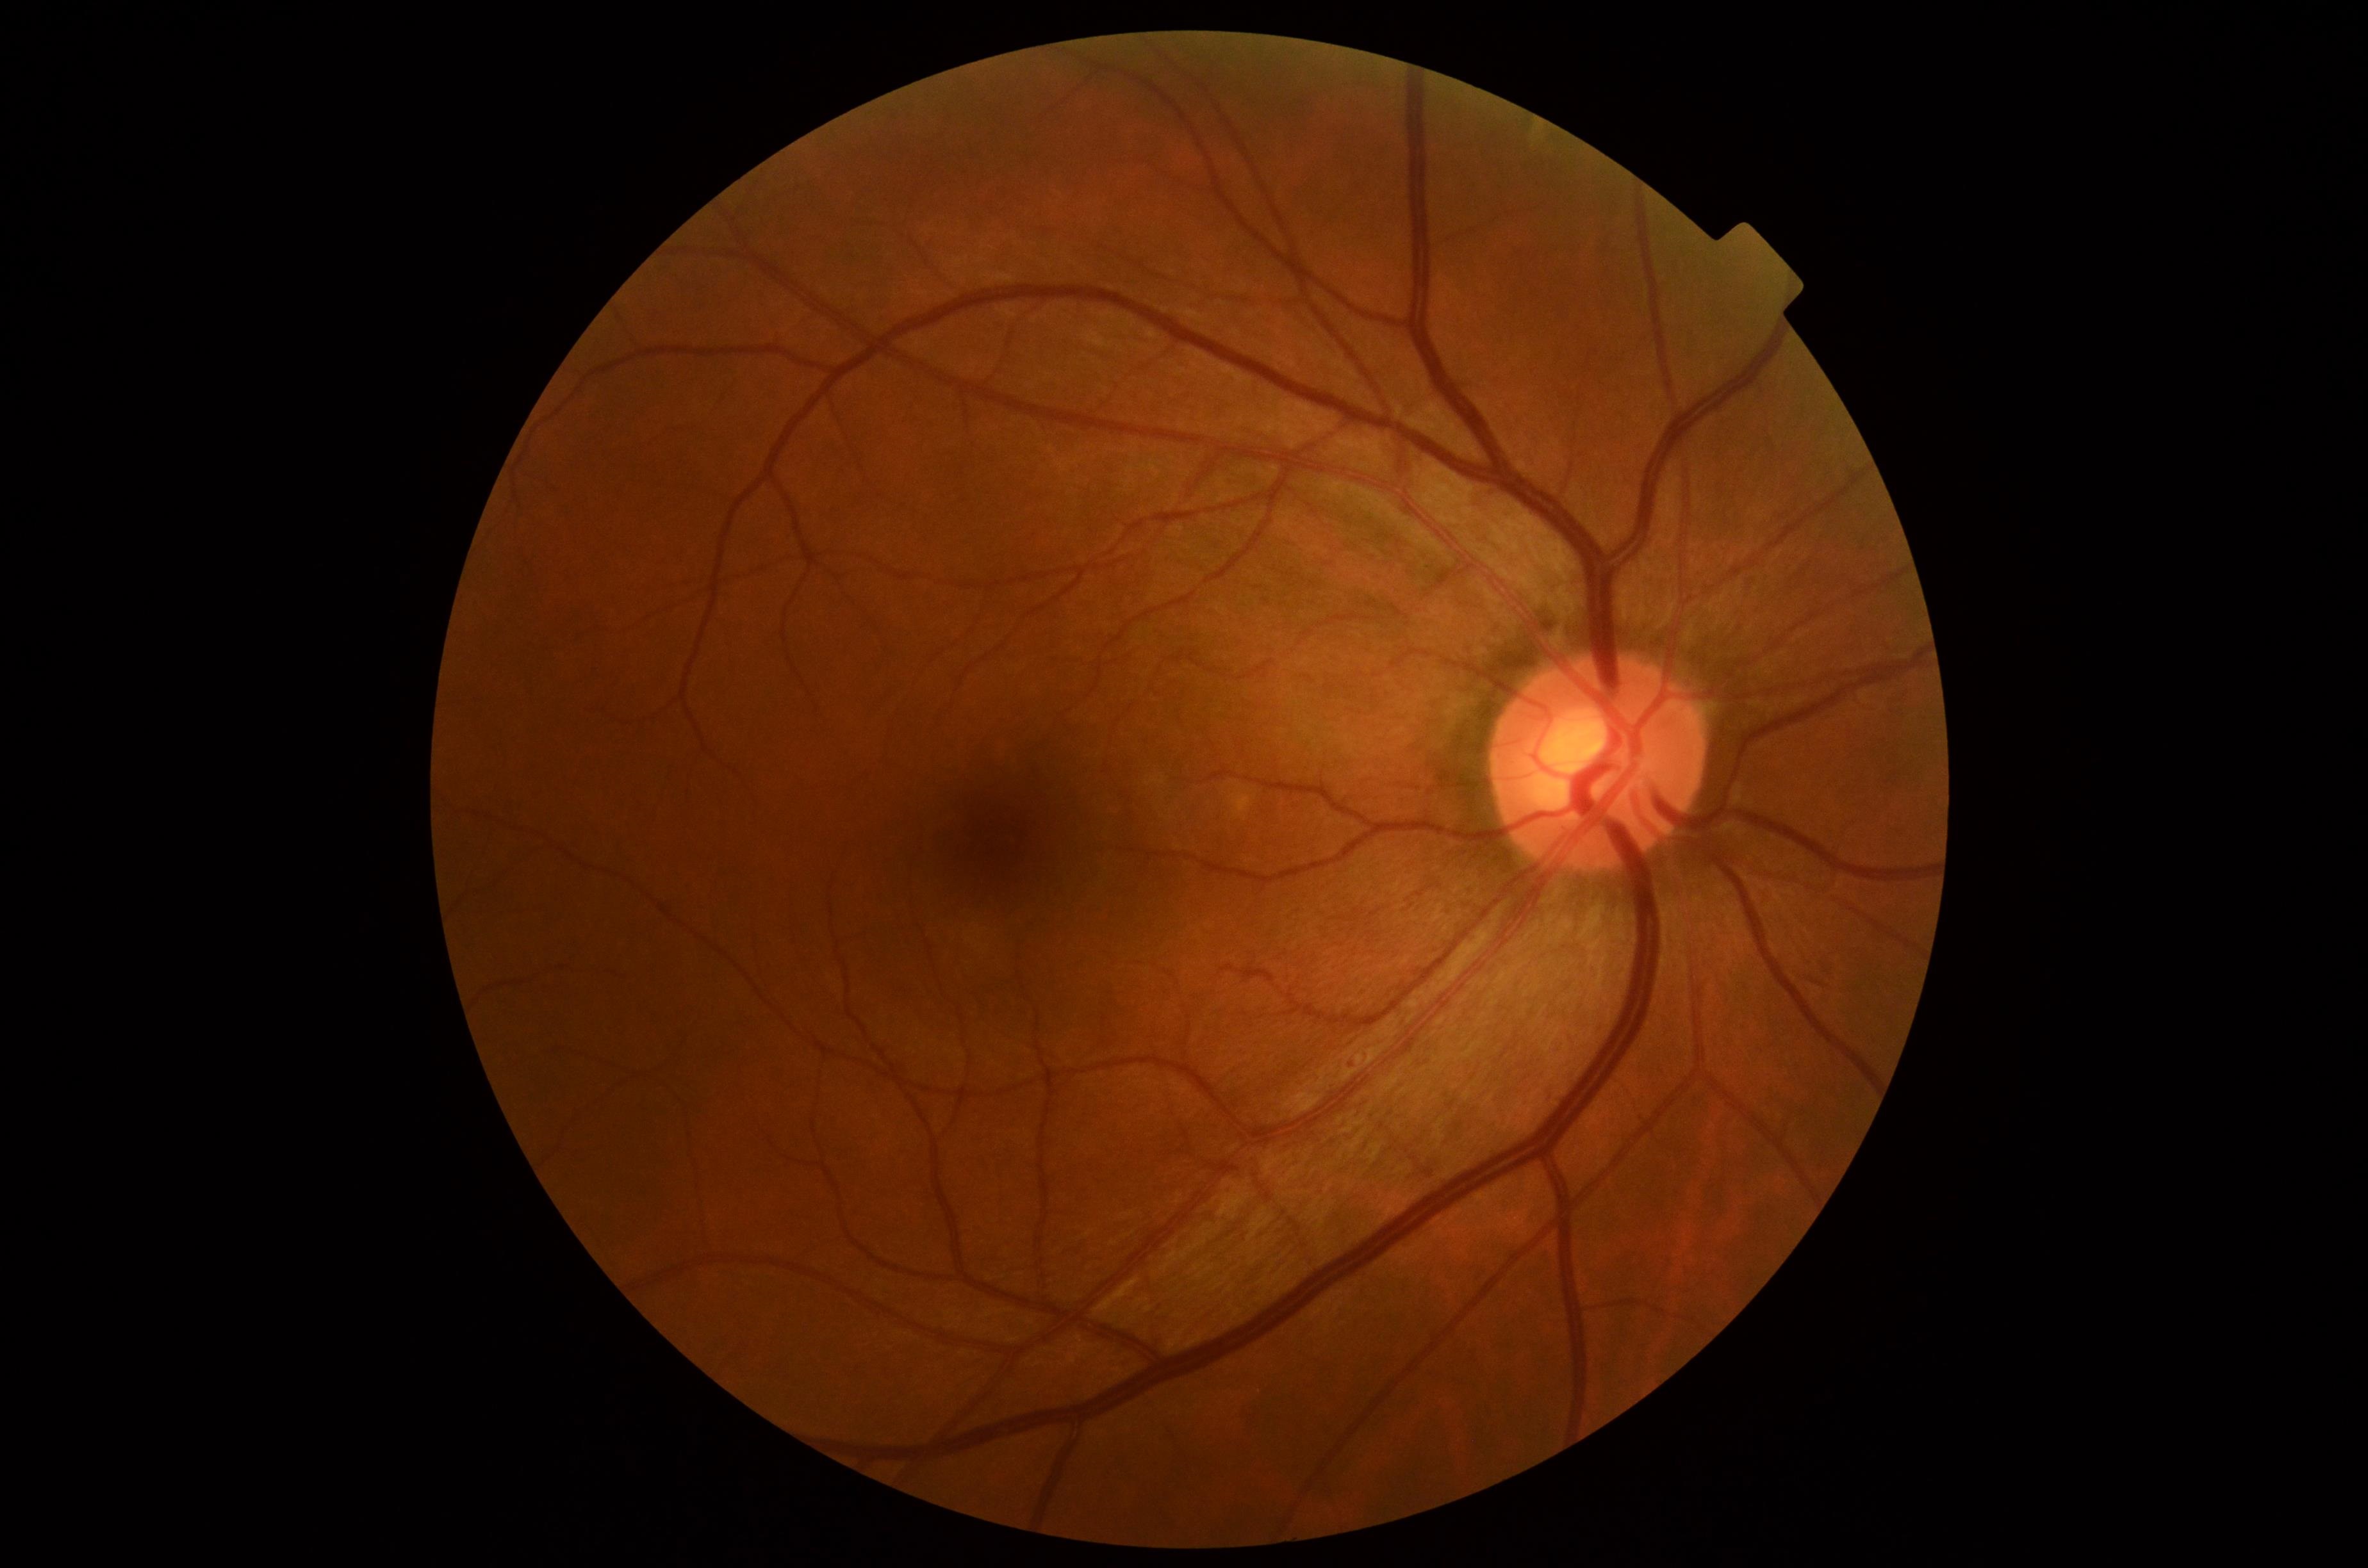

Diabetic retinopathy severity is grade 1 (mild NPDR).